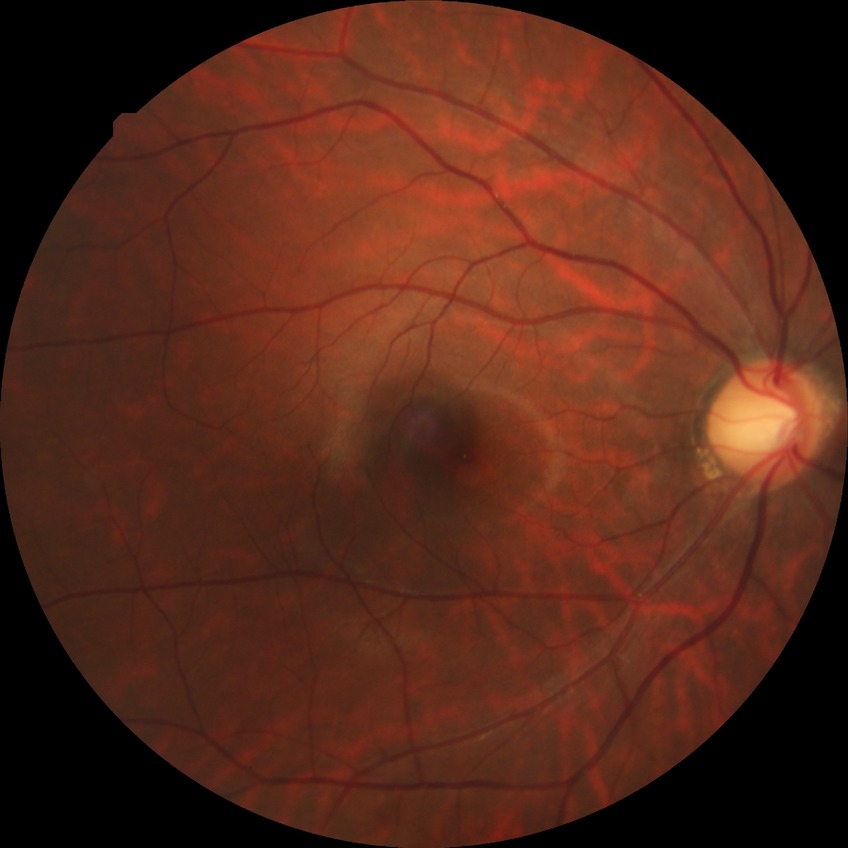 modified Davis grading = no diabetic retinopathy